Retinal fundus photograph:
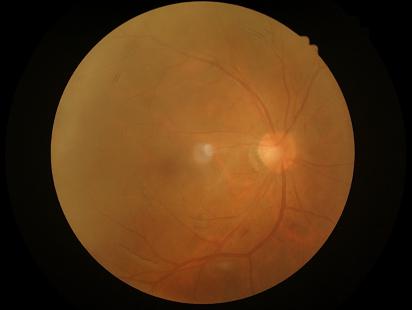

Overall image quality: poor
Sharpness: poor
Contrast: good